240x240px
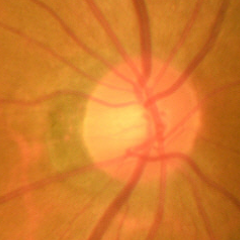

Glaucomatous changes are present. Demonstrates early glaucoma.